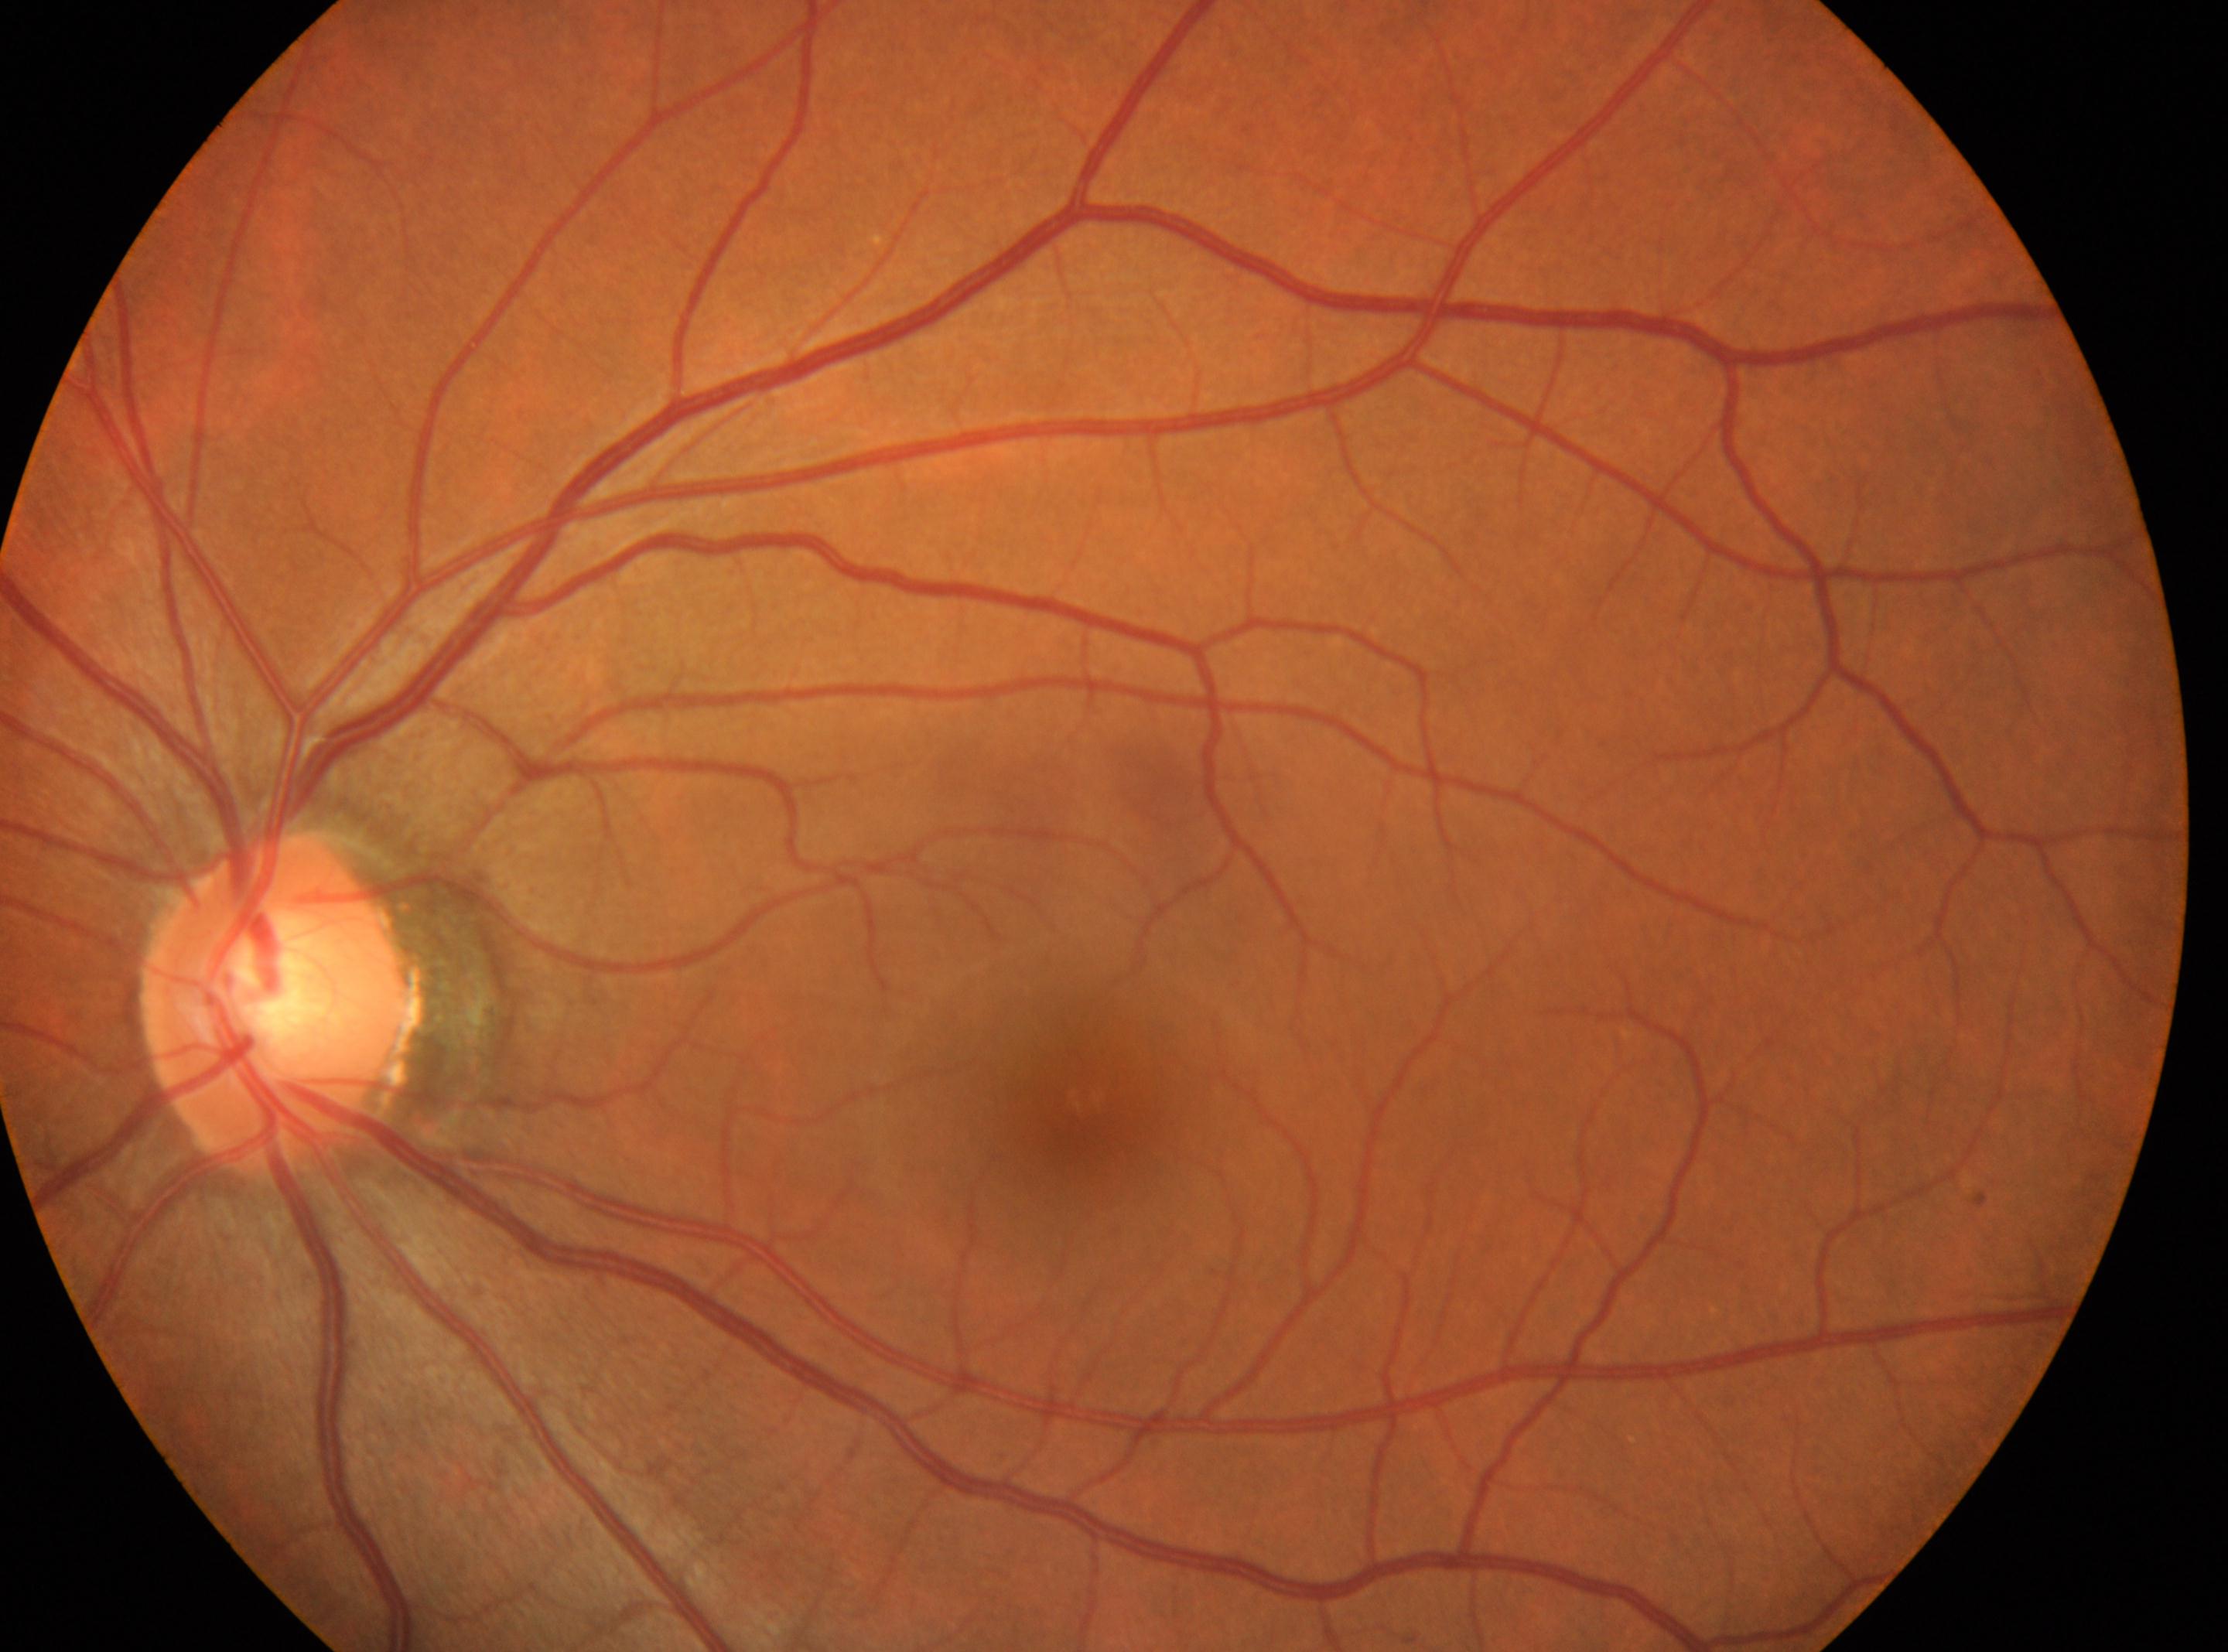
fovea center: (1082,1100); No diabetic retinopathy identified; diabetic retinopathy grade: 0 (no apparent retinopathy); optic disc center: (282,1005); oculus sinister.